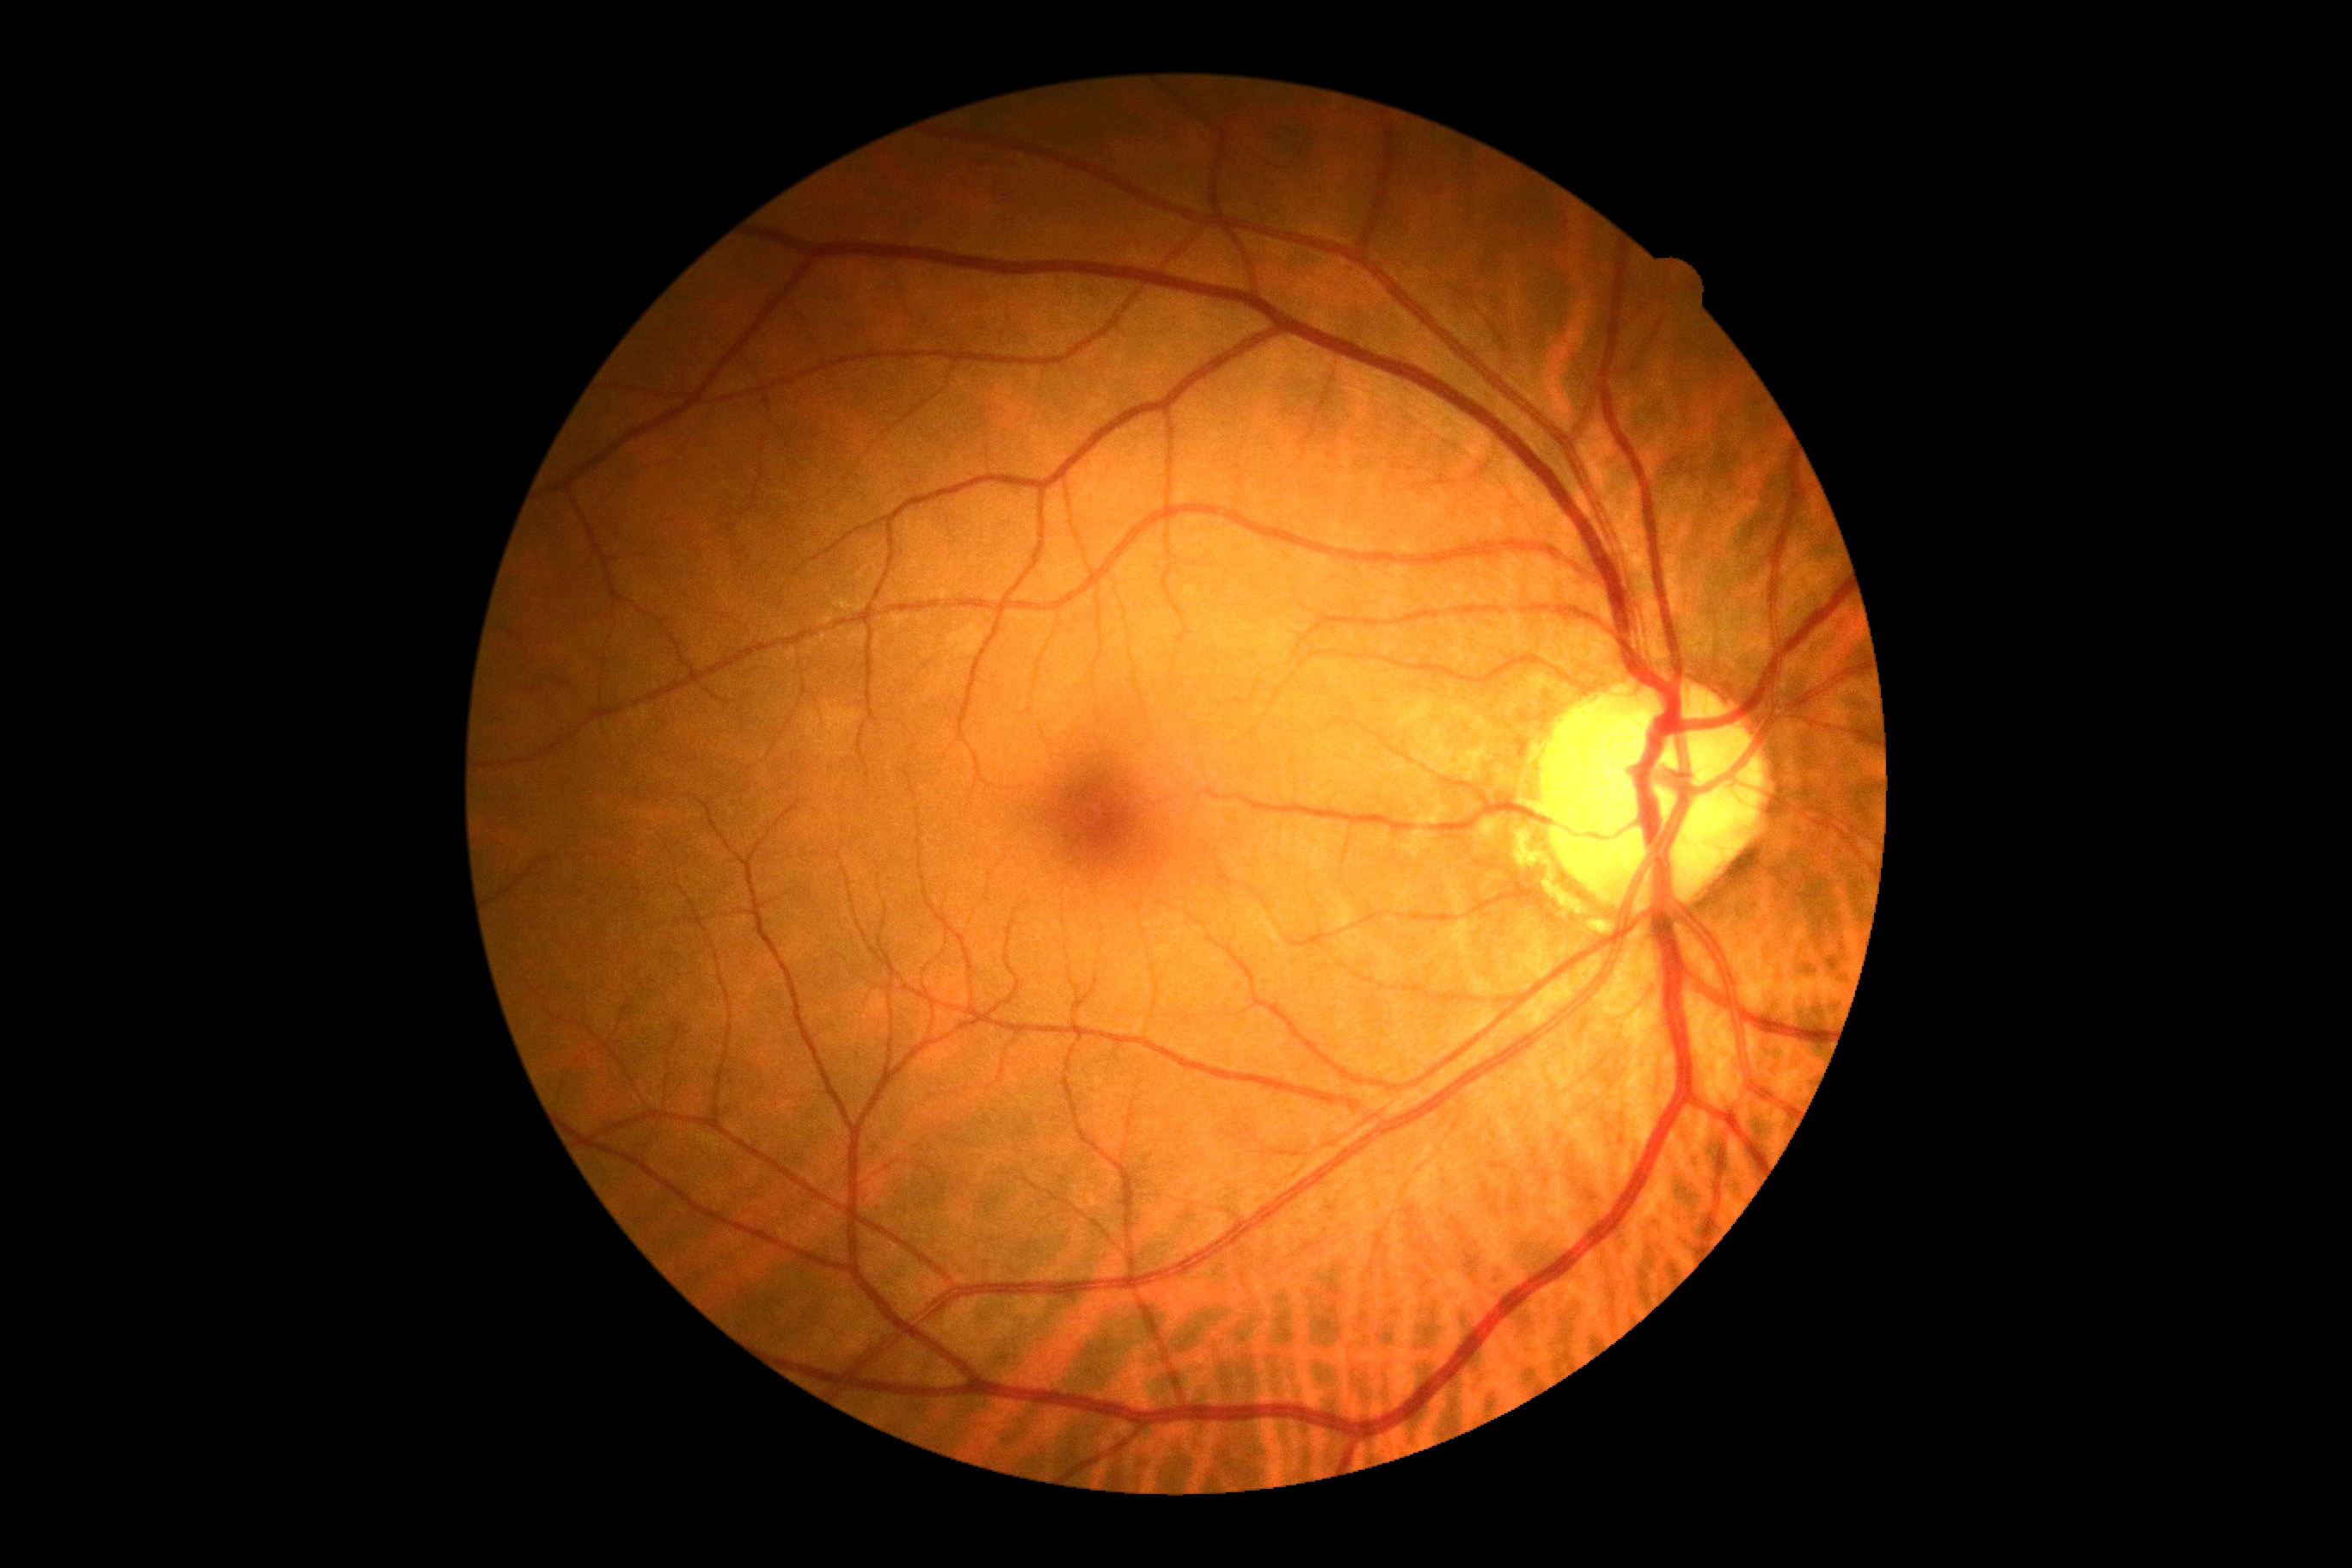 DR grade: 0/4 — no visible signs of diabetic retinopathy.